2212x1659px; retinal fundus photograph: 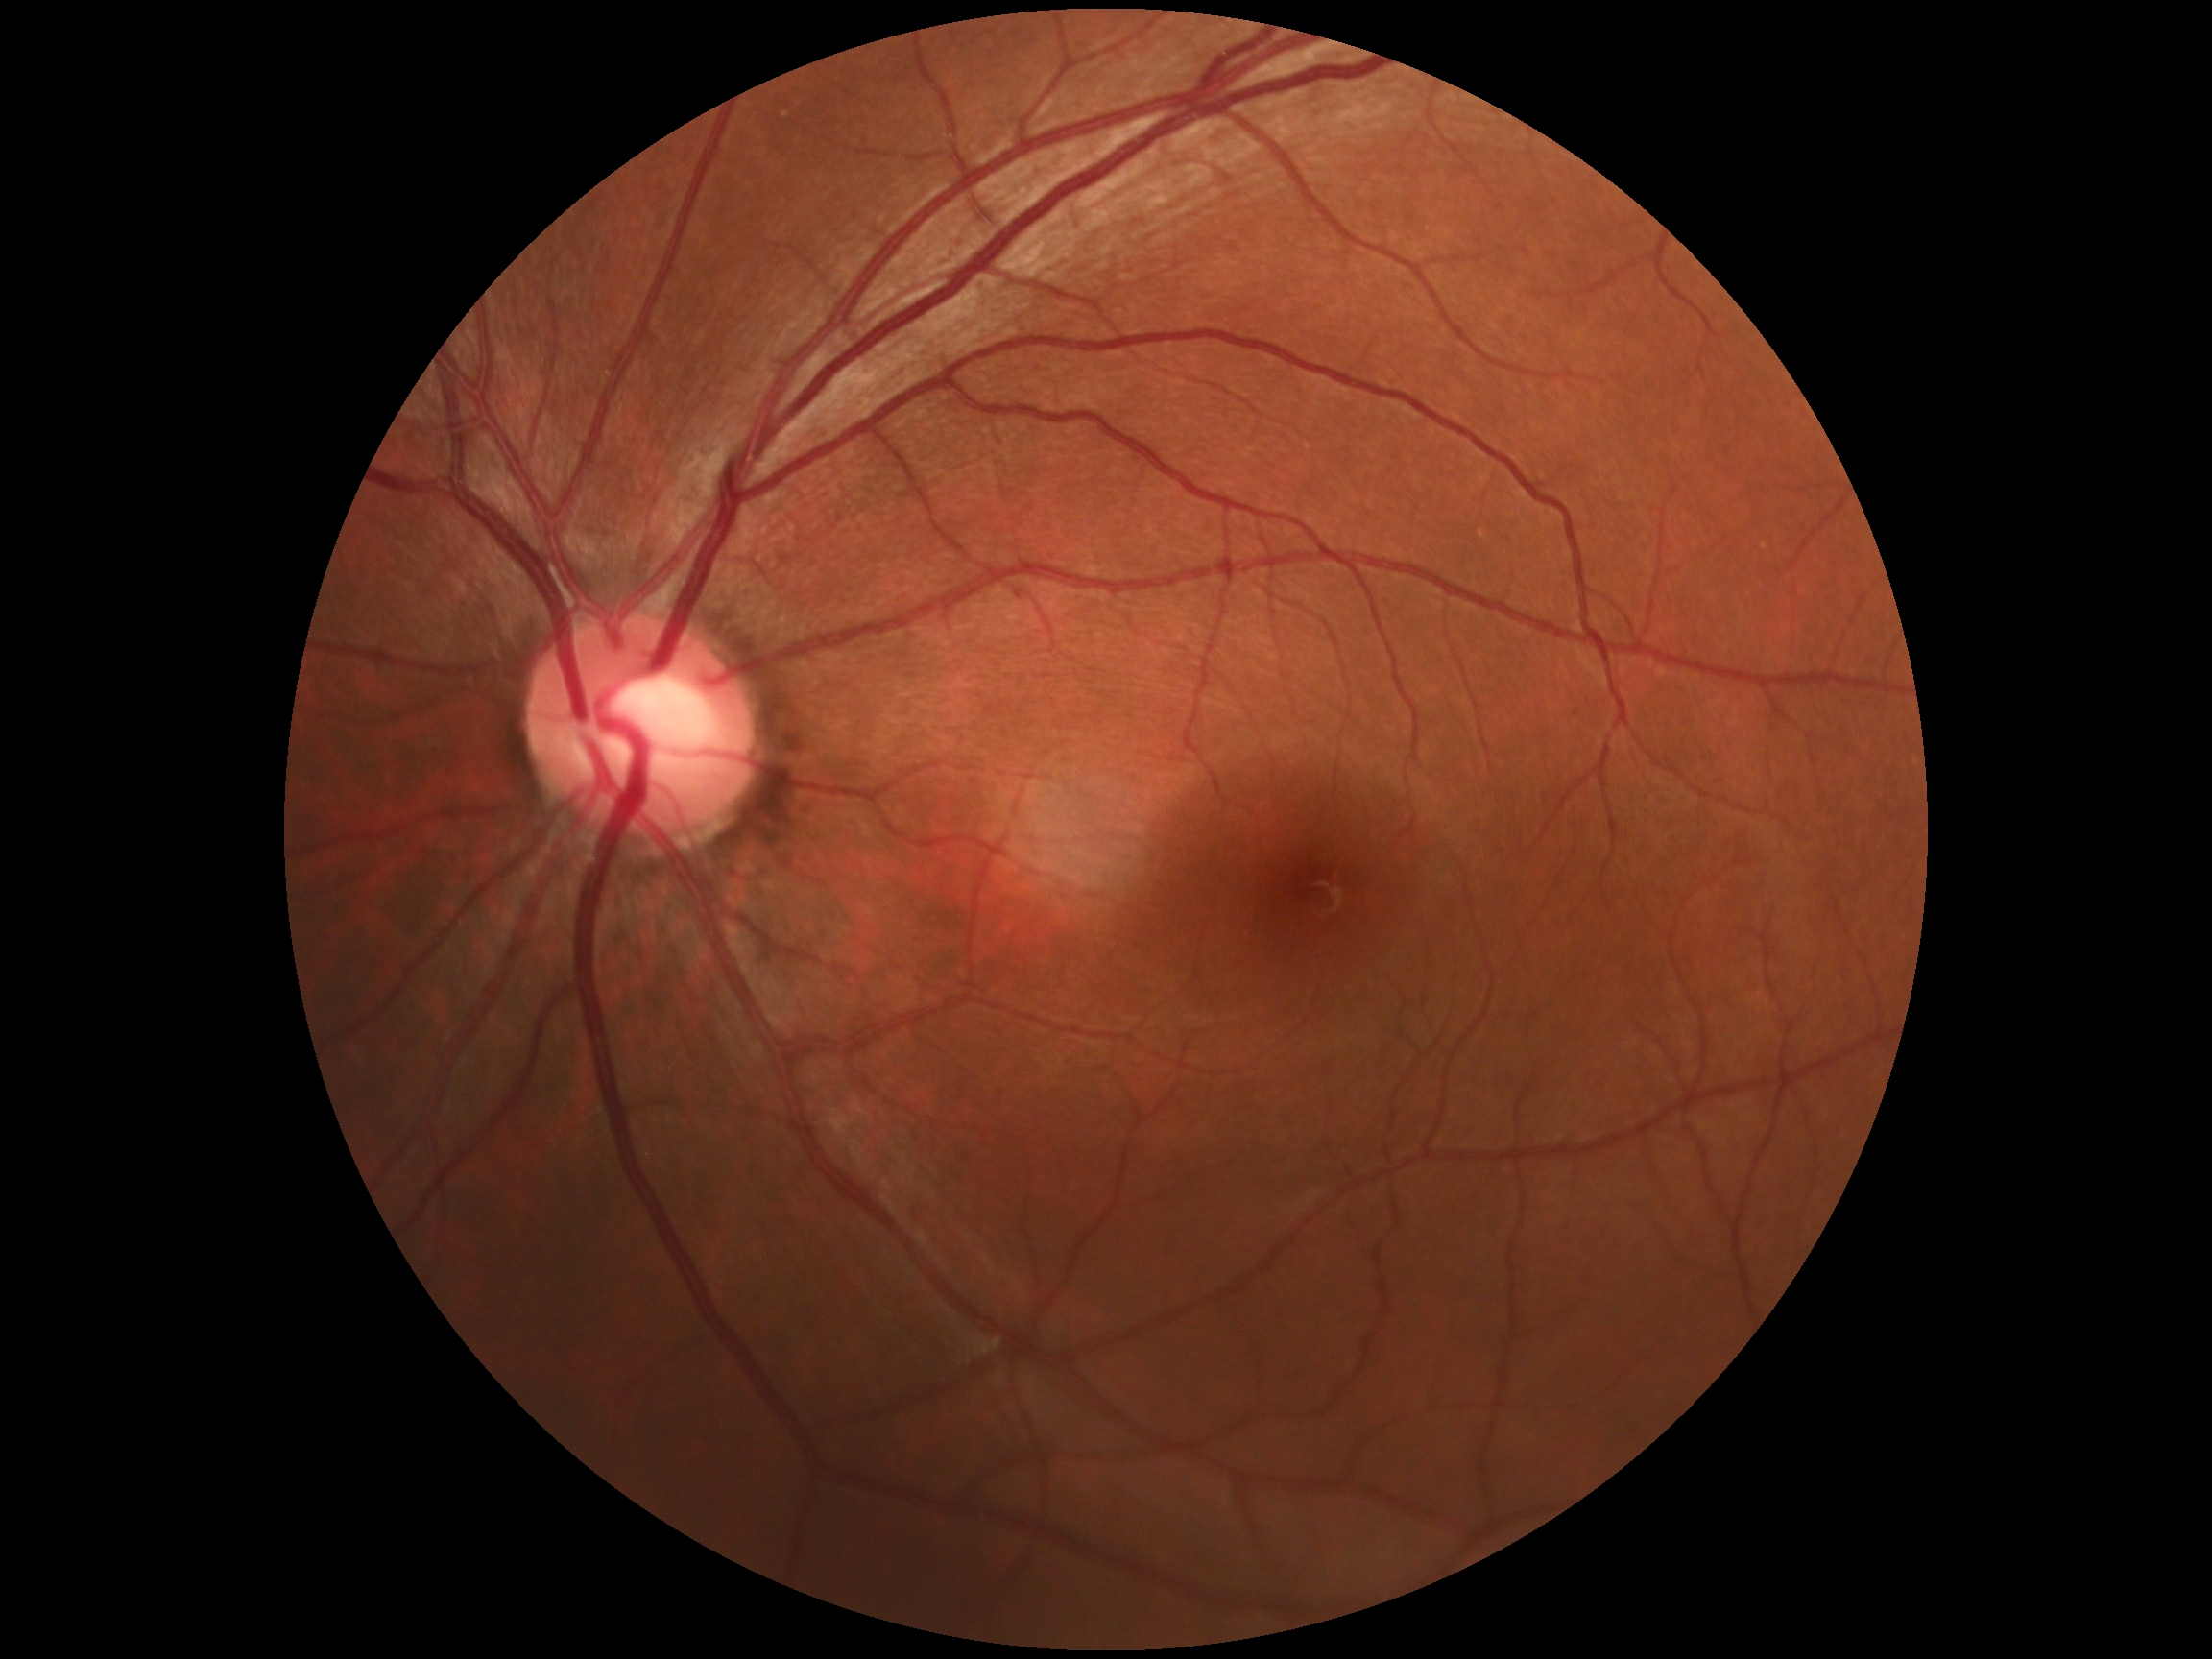
* DR: 0/4 — no visible signs of diabetic retinopathy